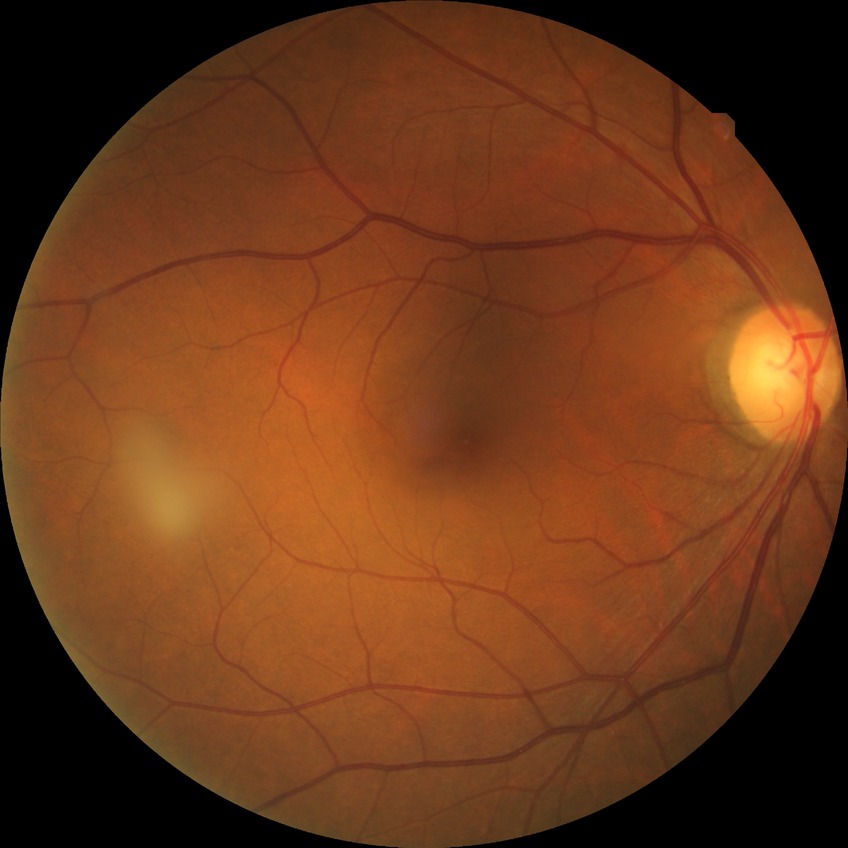

Diabetic retinopathy (DR): no diabetic retinopathy (NDR).